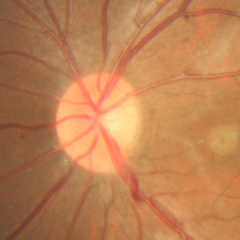
Glaucoma status = no glaucomatous changes.